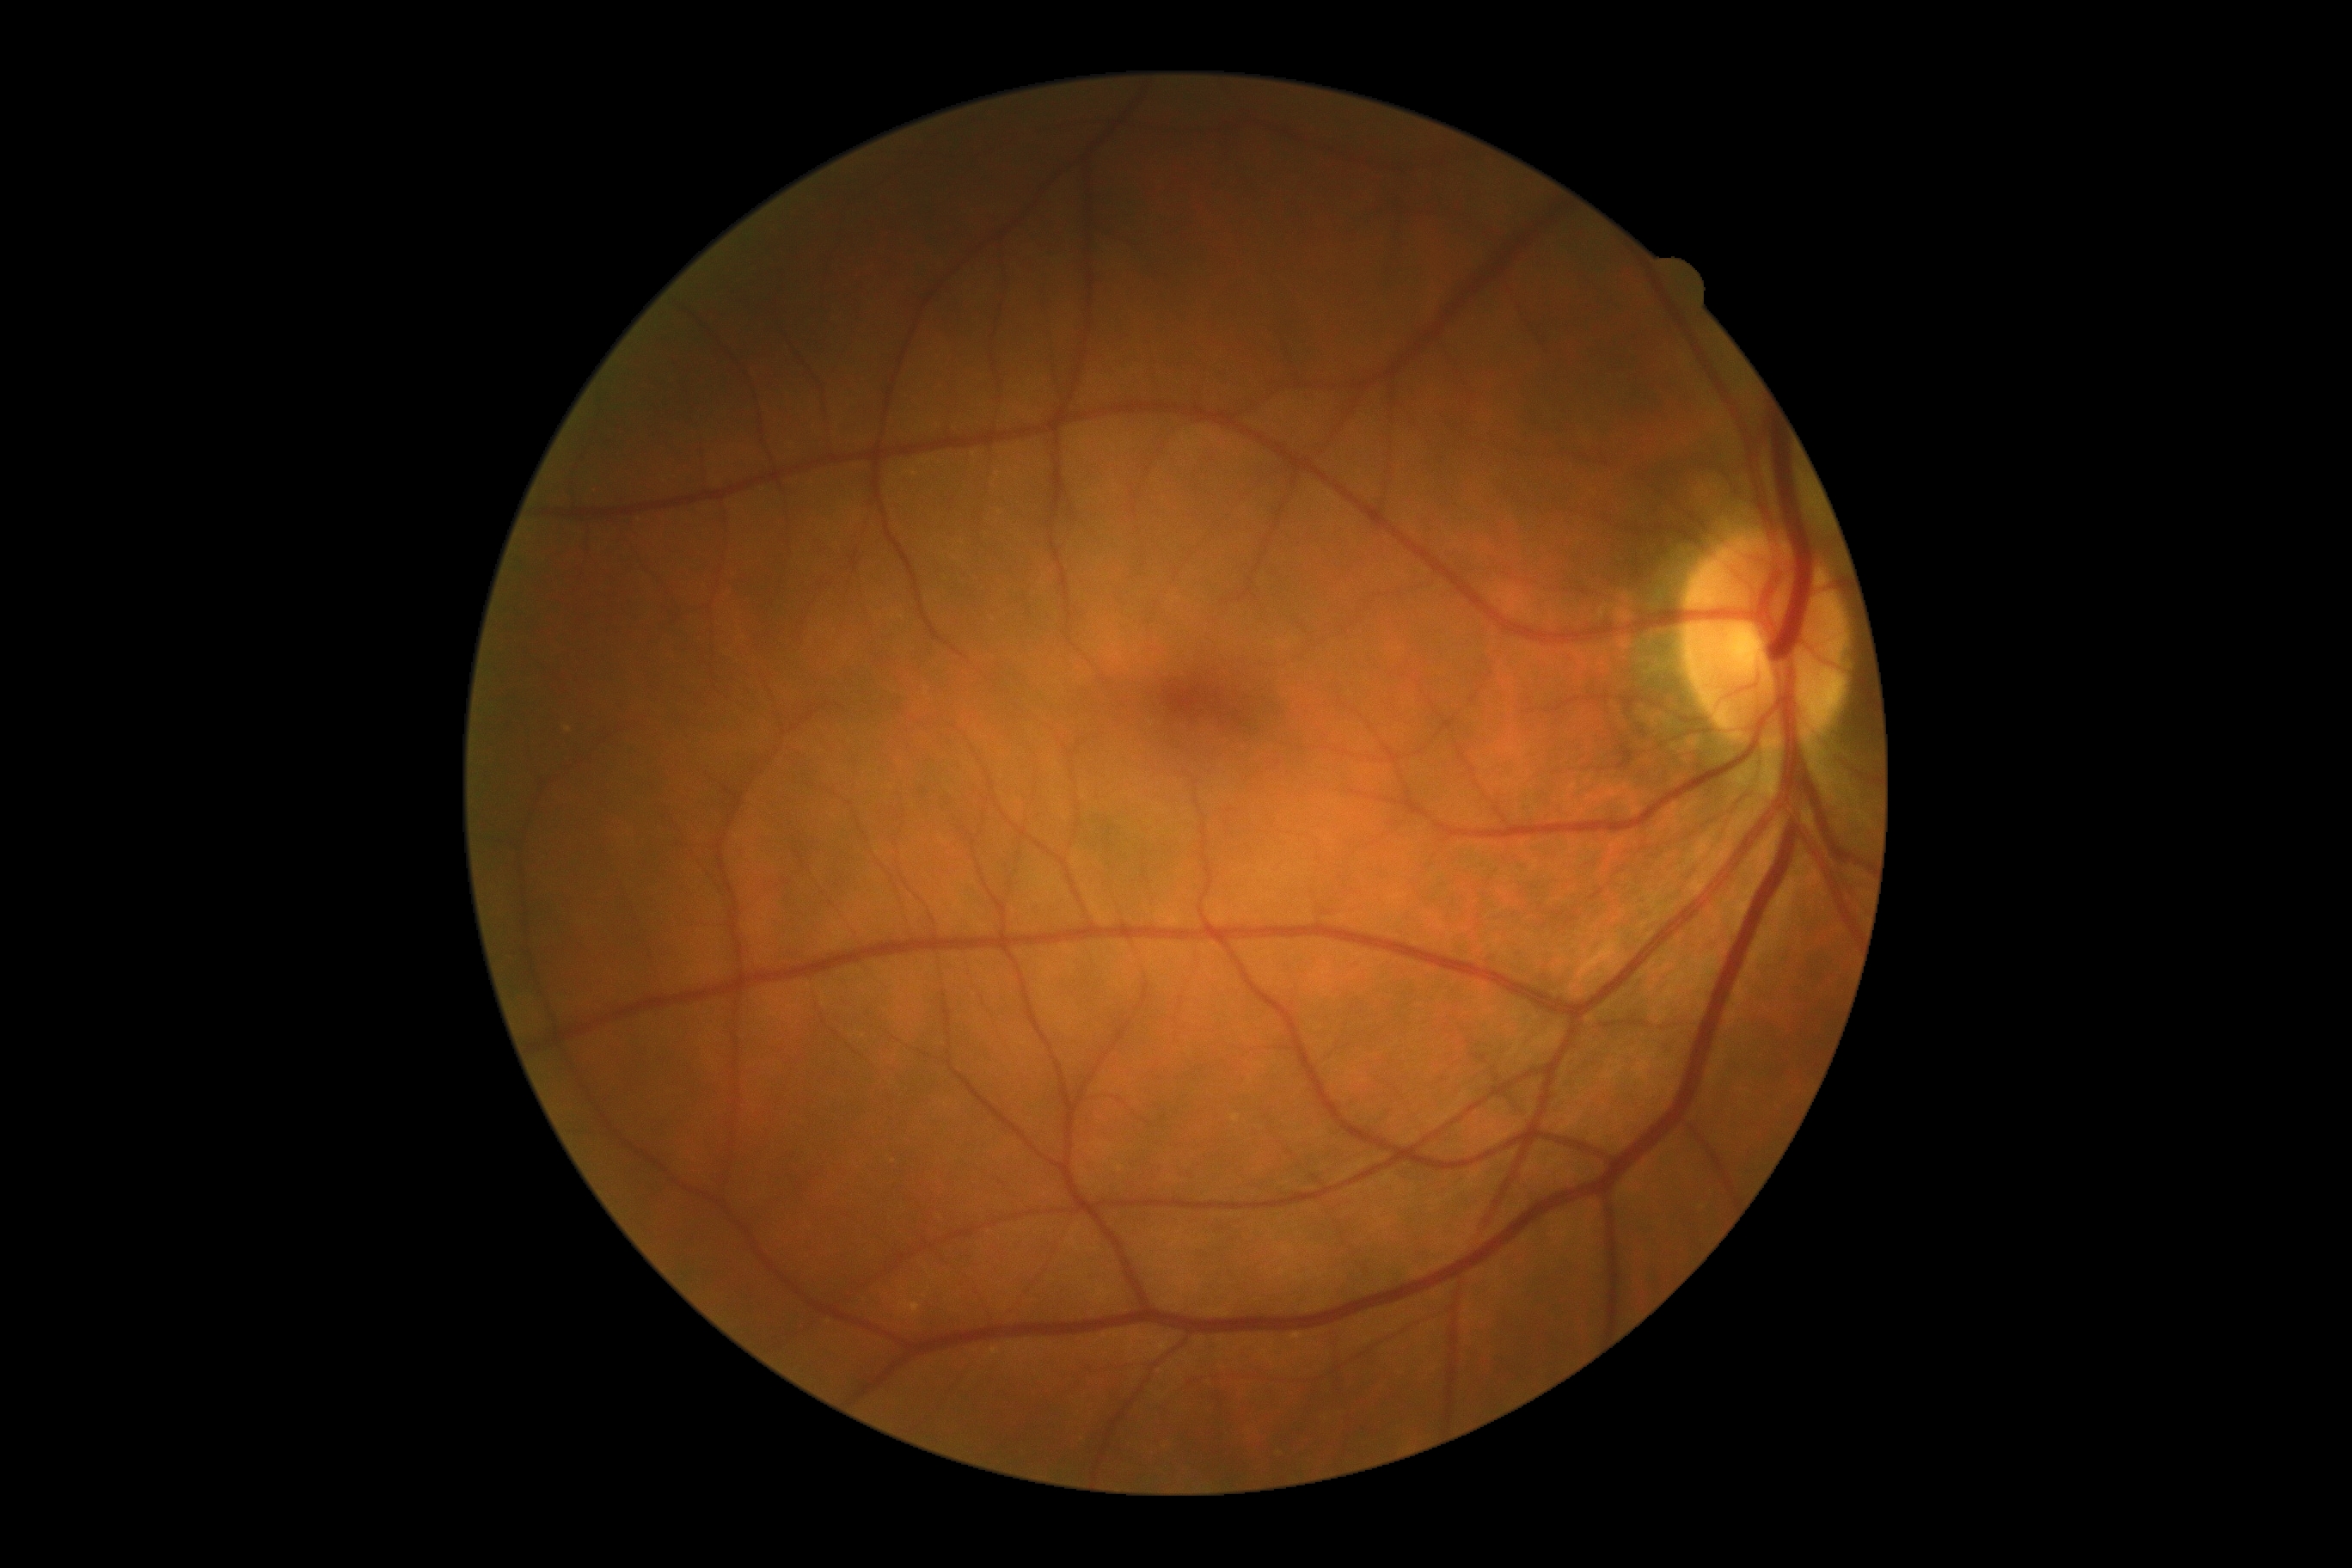
No apparent diabetic retinopathy. DR stage is no apparent diabetic retinopathy (grade 0).